71-year-old patient; disc-centered field; captured on a Topcon TRC-NW400 fundus camera; intraocular pressure 14 mmHg; sex: male; captured without pupil dilation; 2212x1661px: 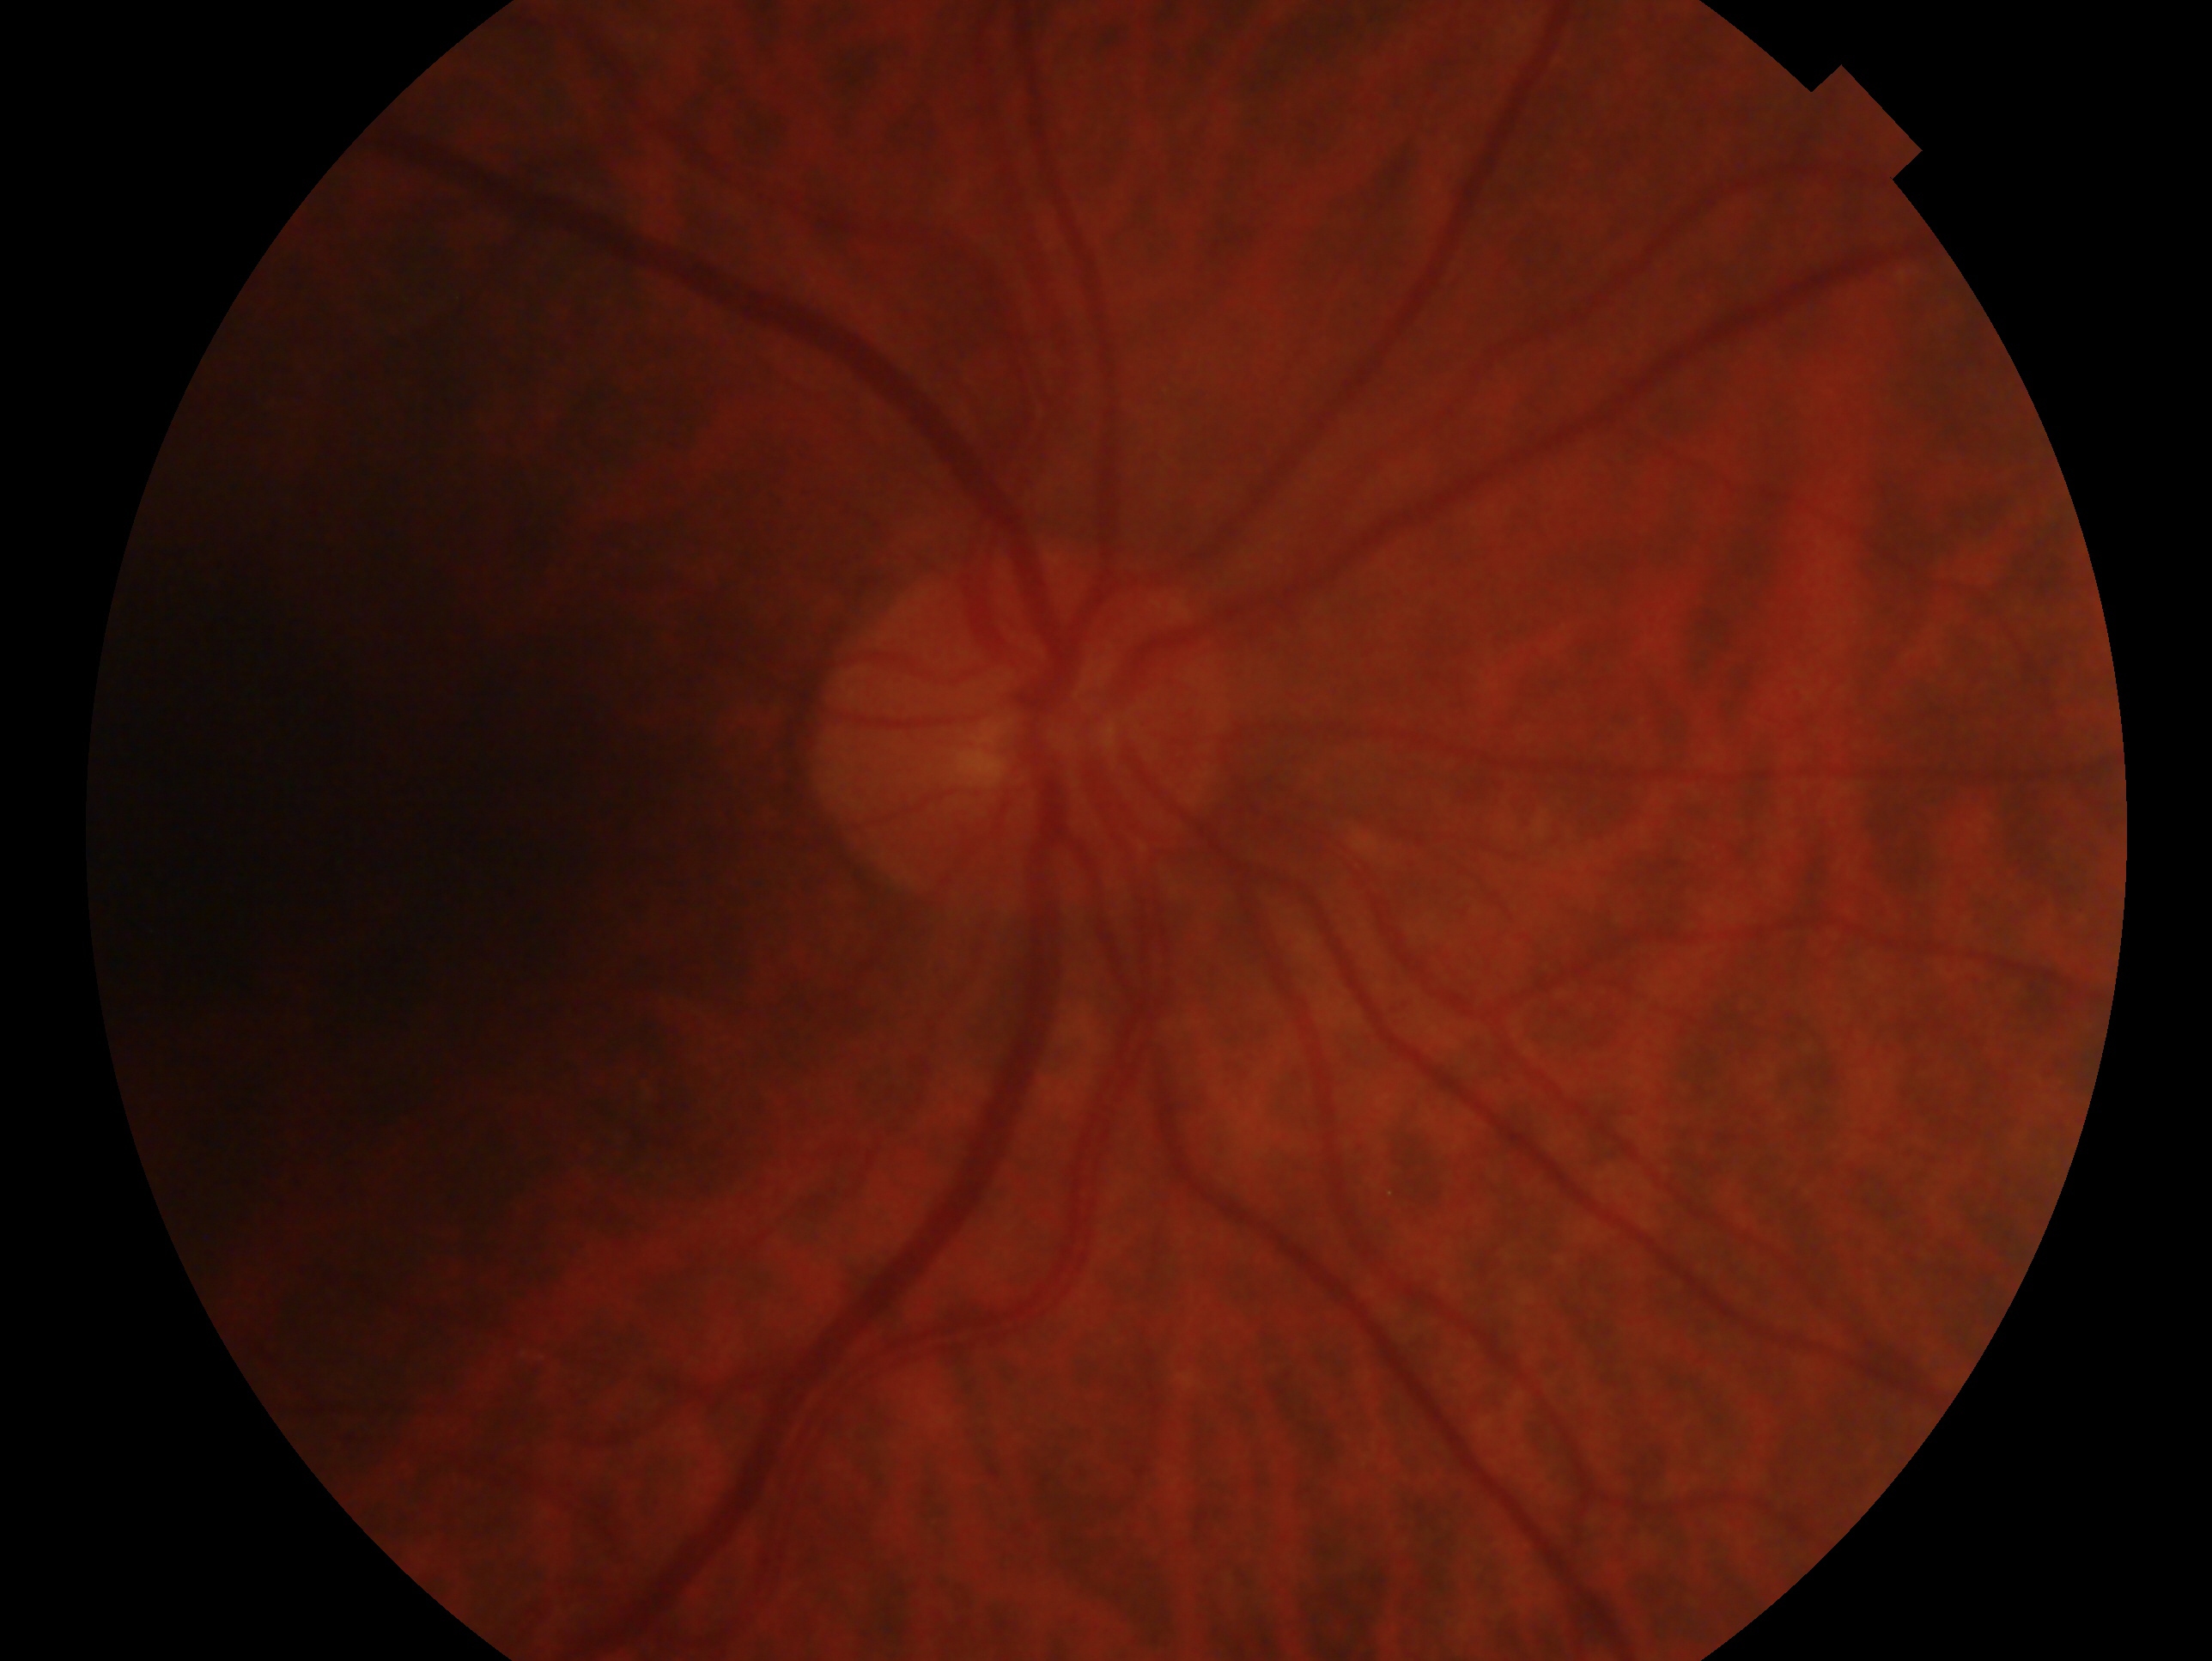

The image shows the OD.
Glaucoma assessment: no evidence of glaucoma.